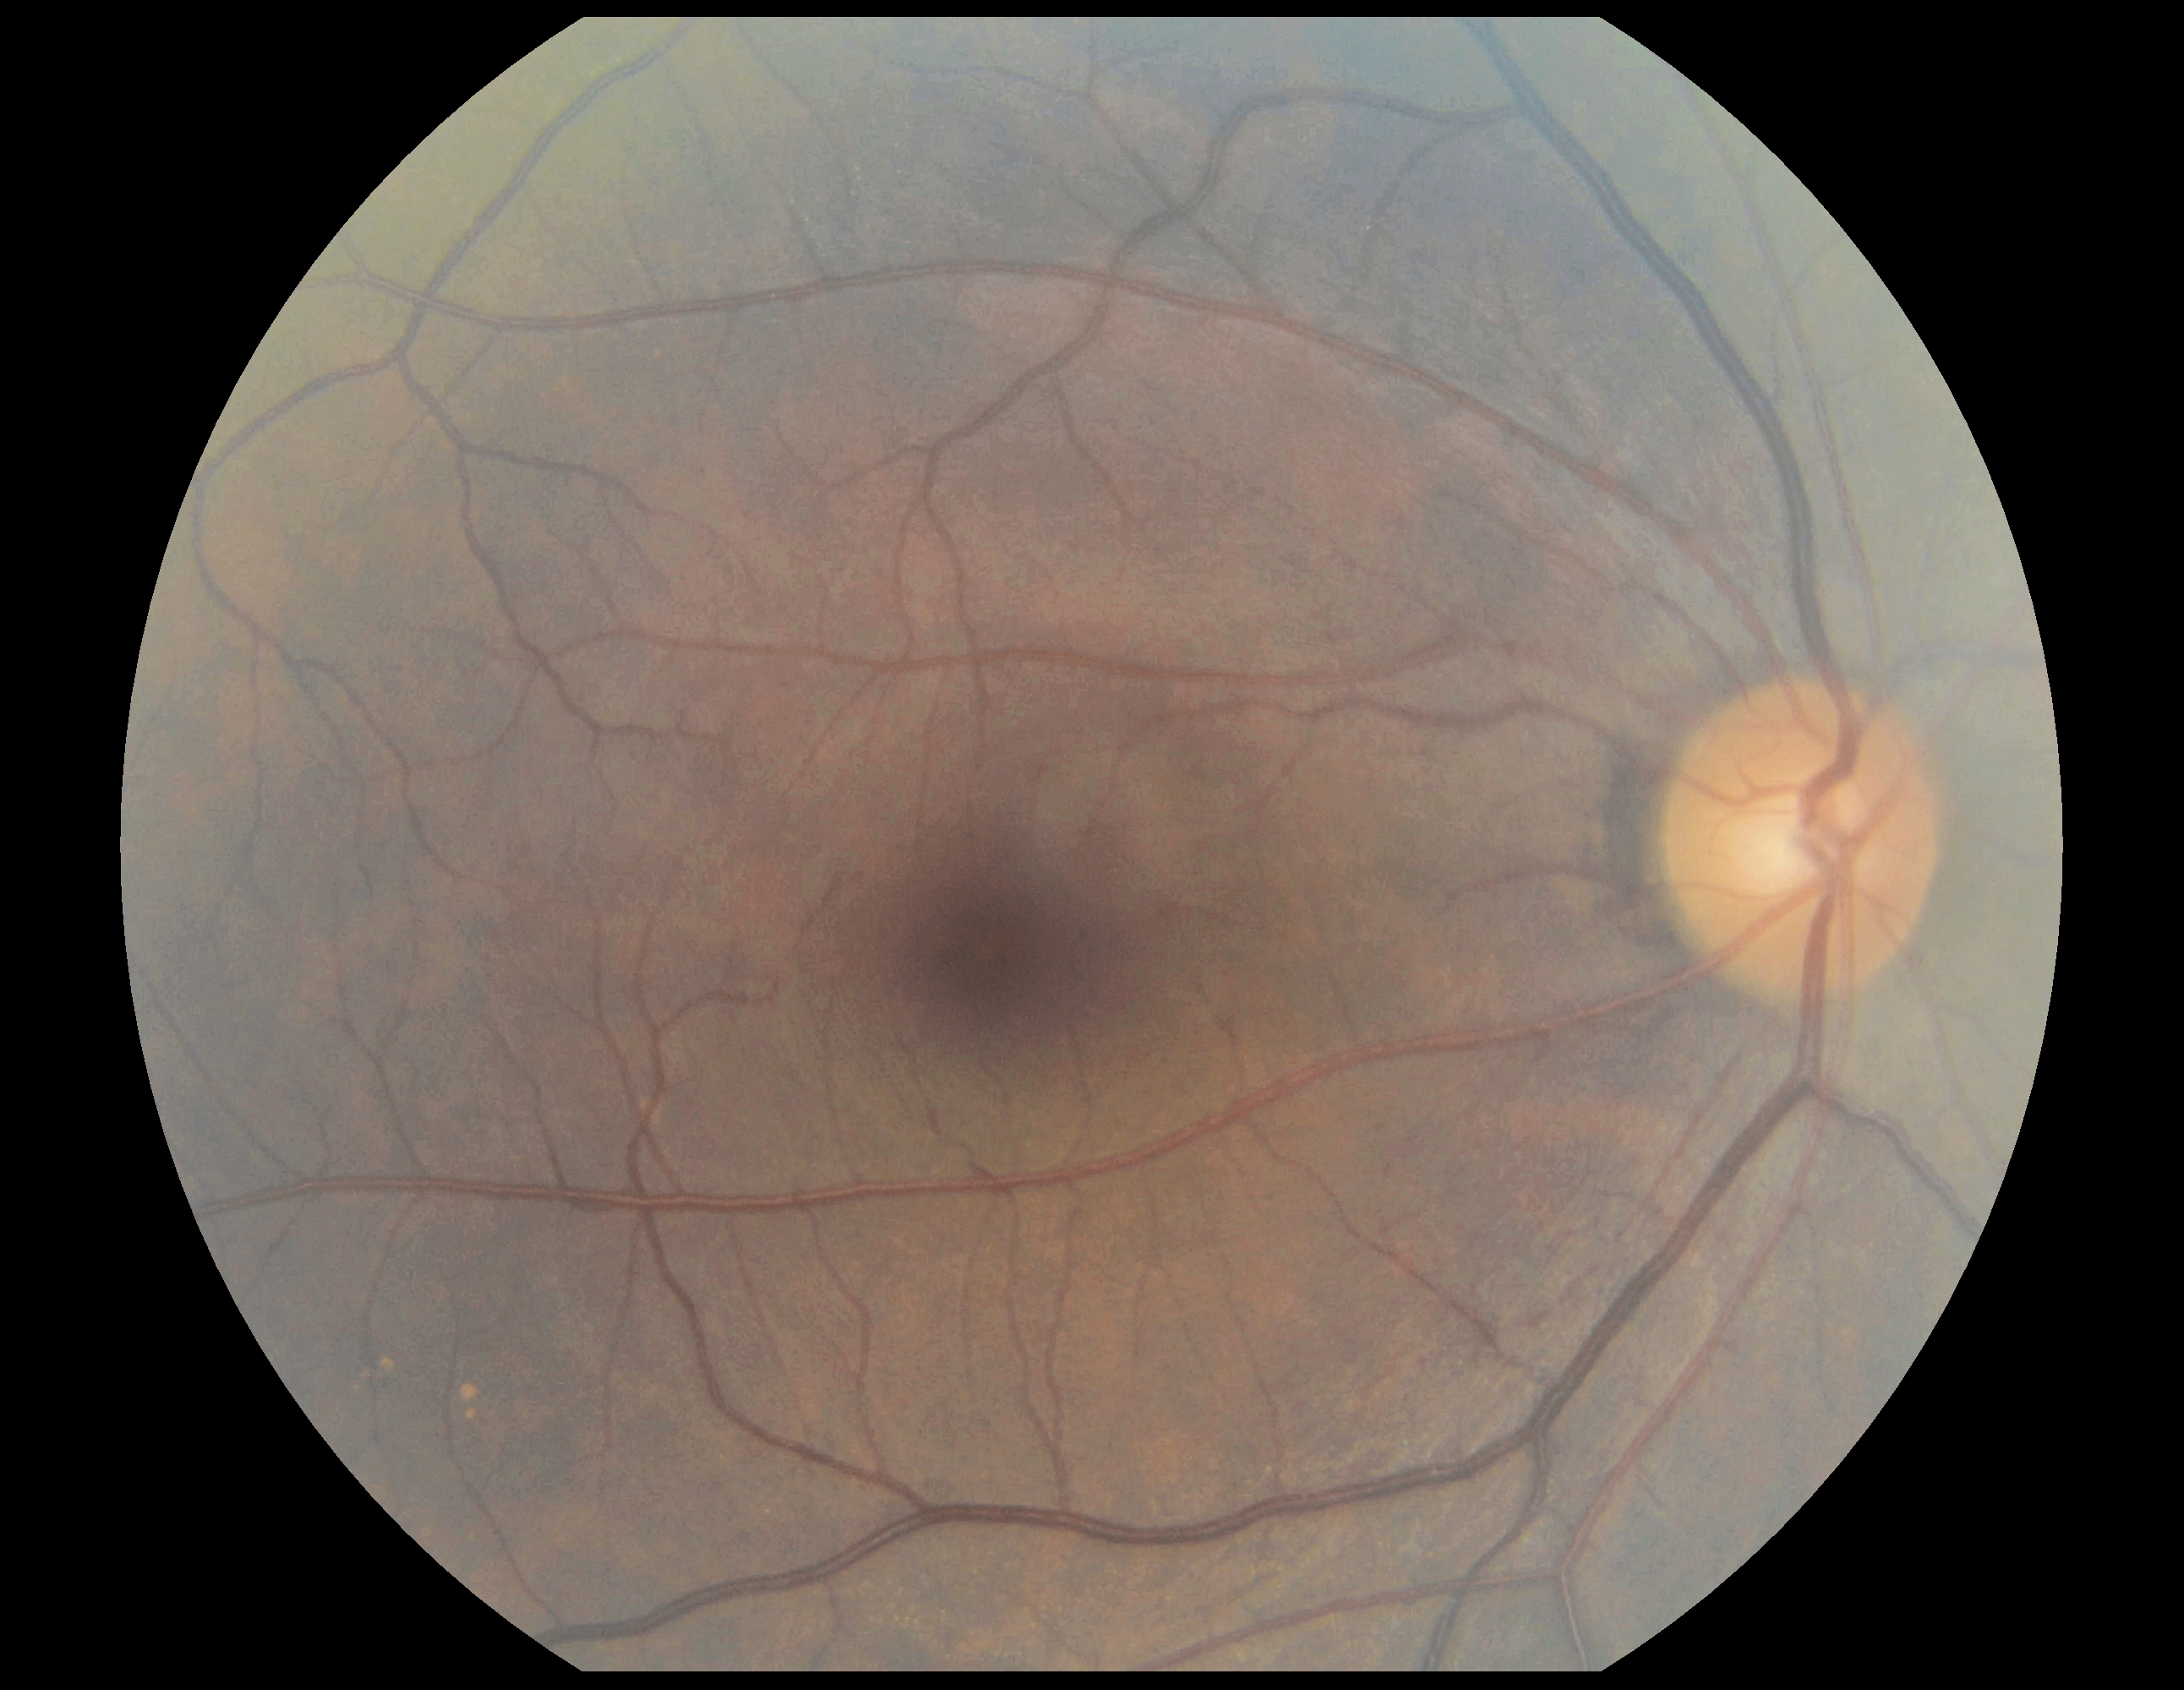 DR stage = grade 0 (no apparent retinopathy).